Fundus photo:
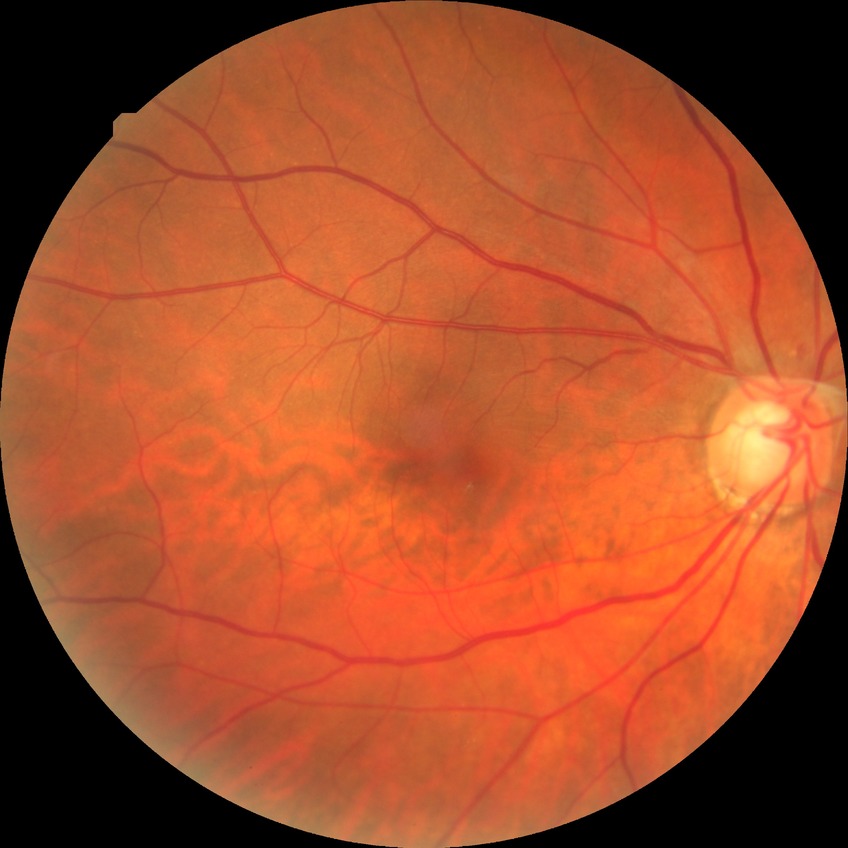

Annotations:
– diabetic retinopathy (DR): NDR (no diabetic retinopathy)